Graded on the modified Davis scale — 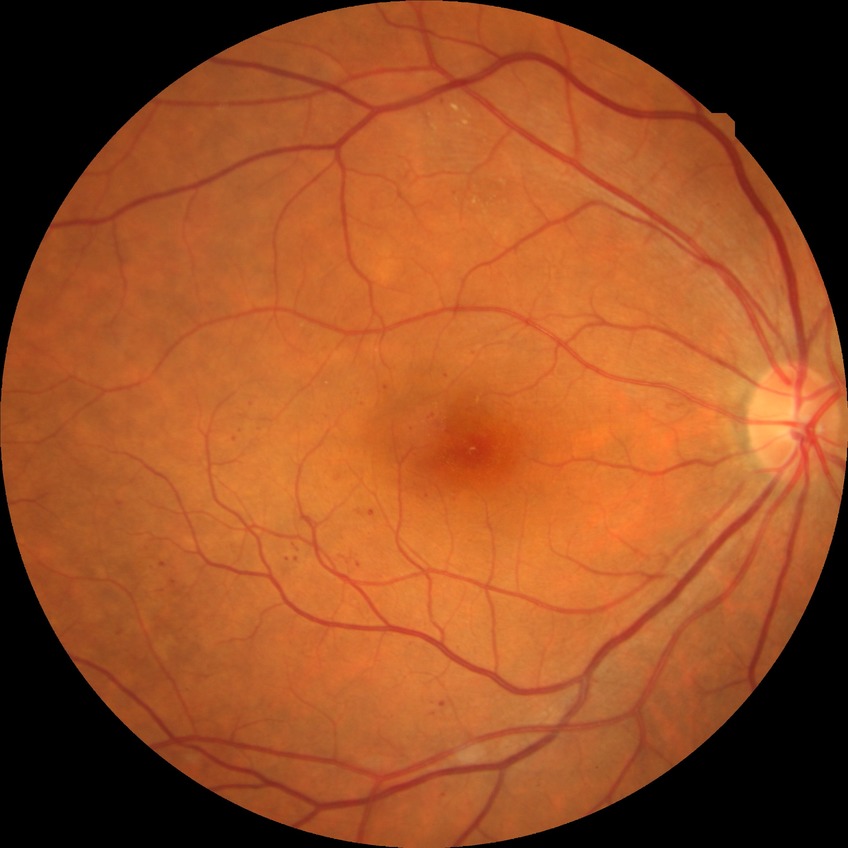 Diabetic retinopathy grade: simple diabetic retinopathy.